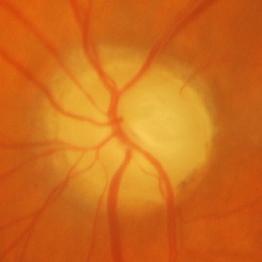

Glaucoma is present. Consistent with glaucomatous optic neuropathy.